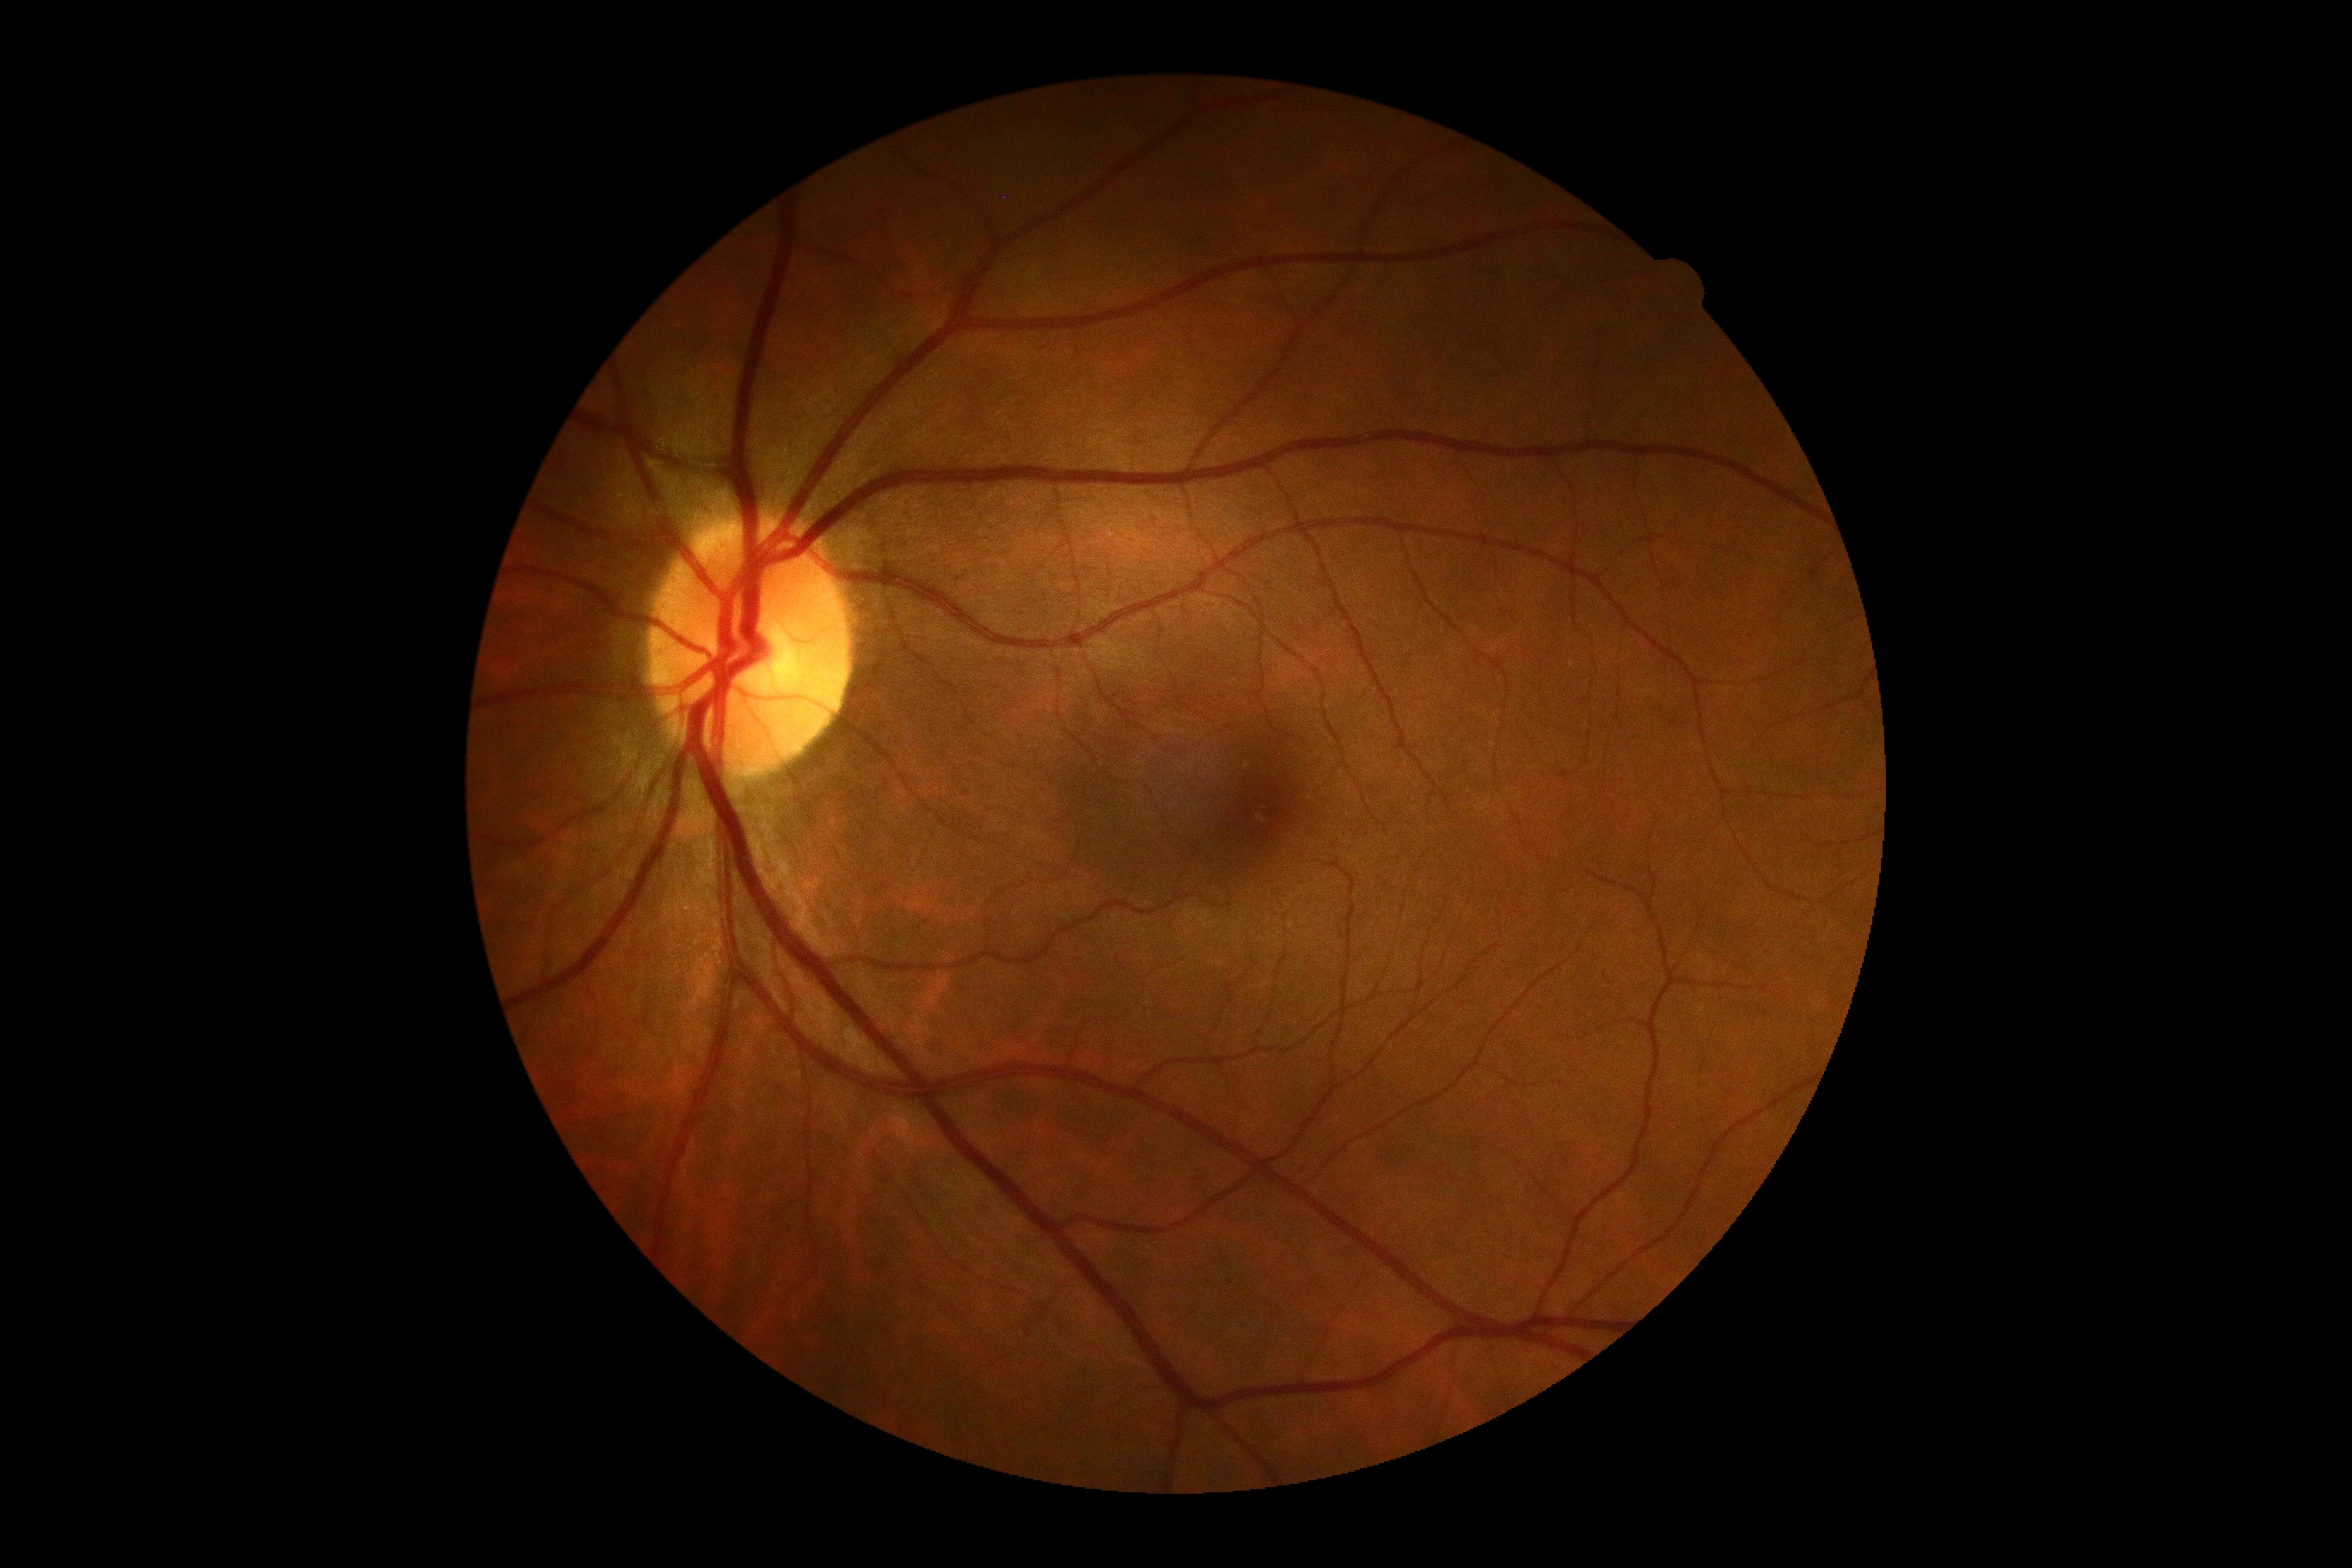
DR severity = no apparent retinopathy (grade 0).